Nonmydriatic fundus photograph, 45° FOV.
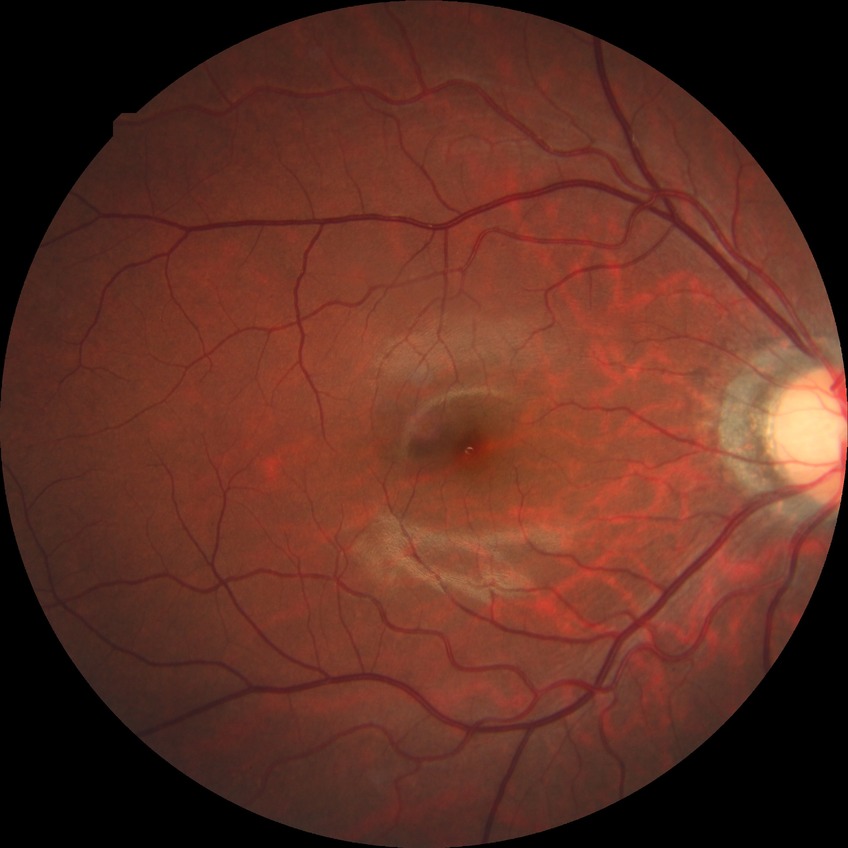 DR impression = no apparent DR | Davis stage = NDR.